Wide-field fundus photograph of an infant · acquired on the Clarity RetCam 3 — 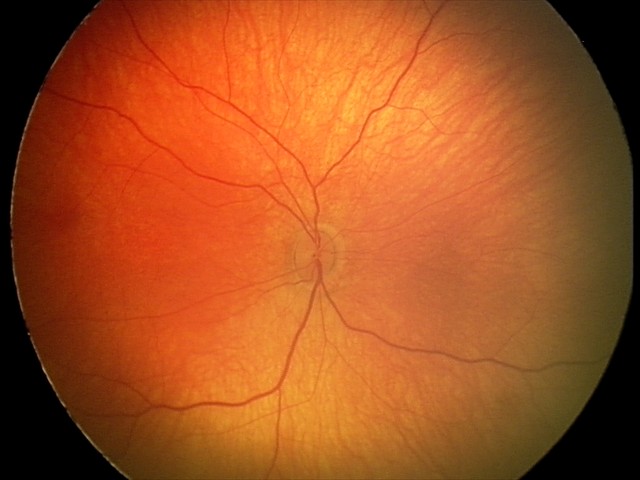

From an examination with diagnosis of retinal hemorrhages.